RetCam wide-field infant fundus image. Acquired on the Clarity RetCam 3:
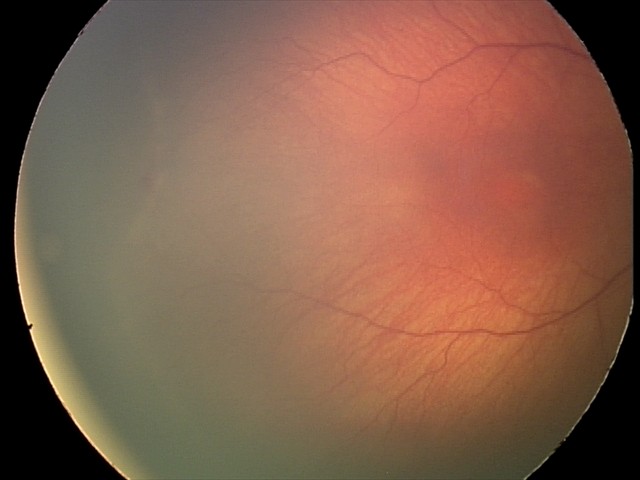

Q: What is the diagnosis from this examination?
A: retinopathy of prematurity stage 1